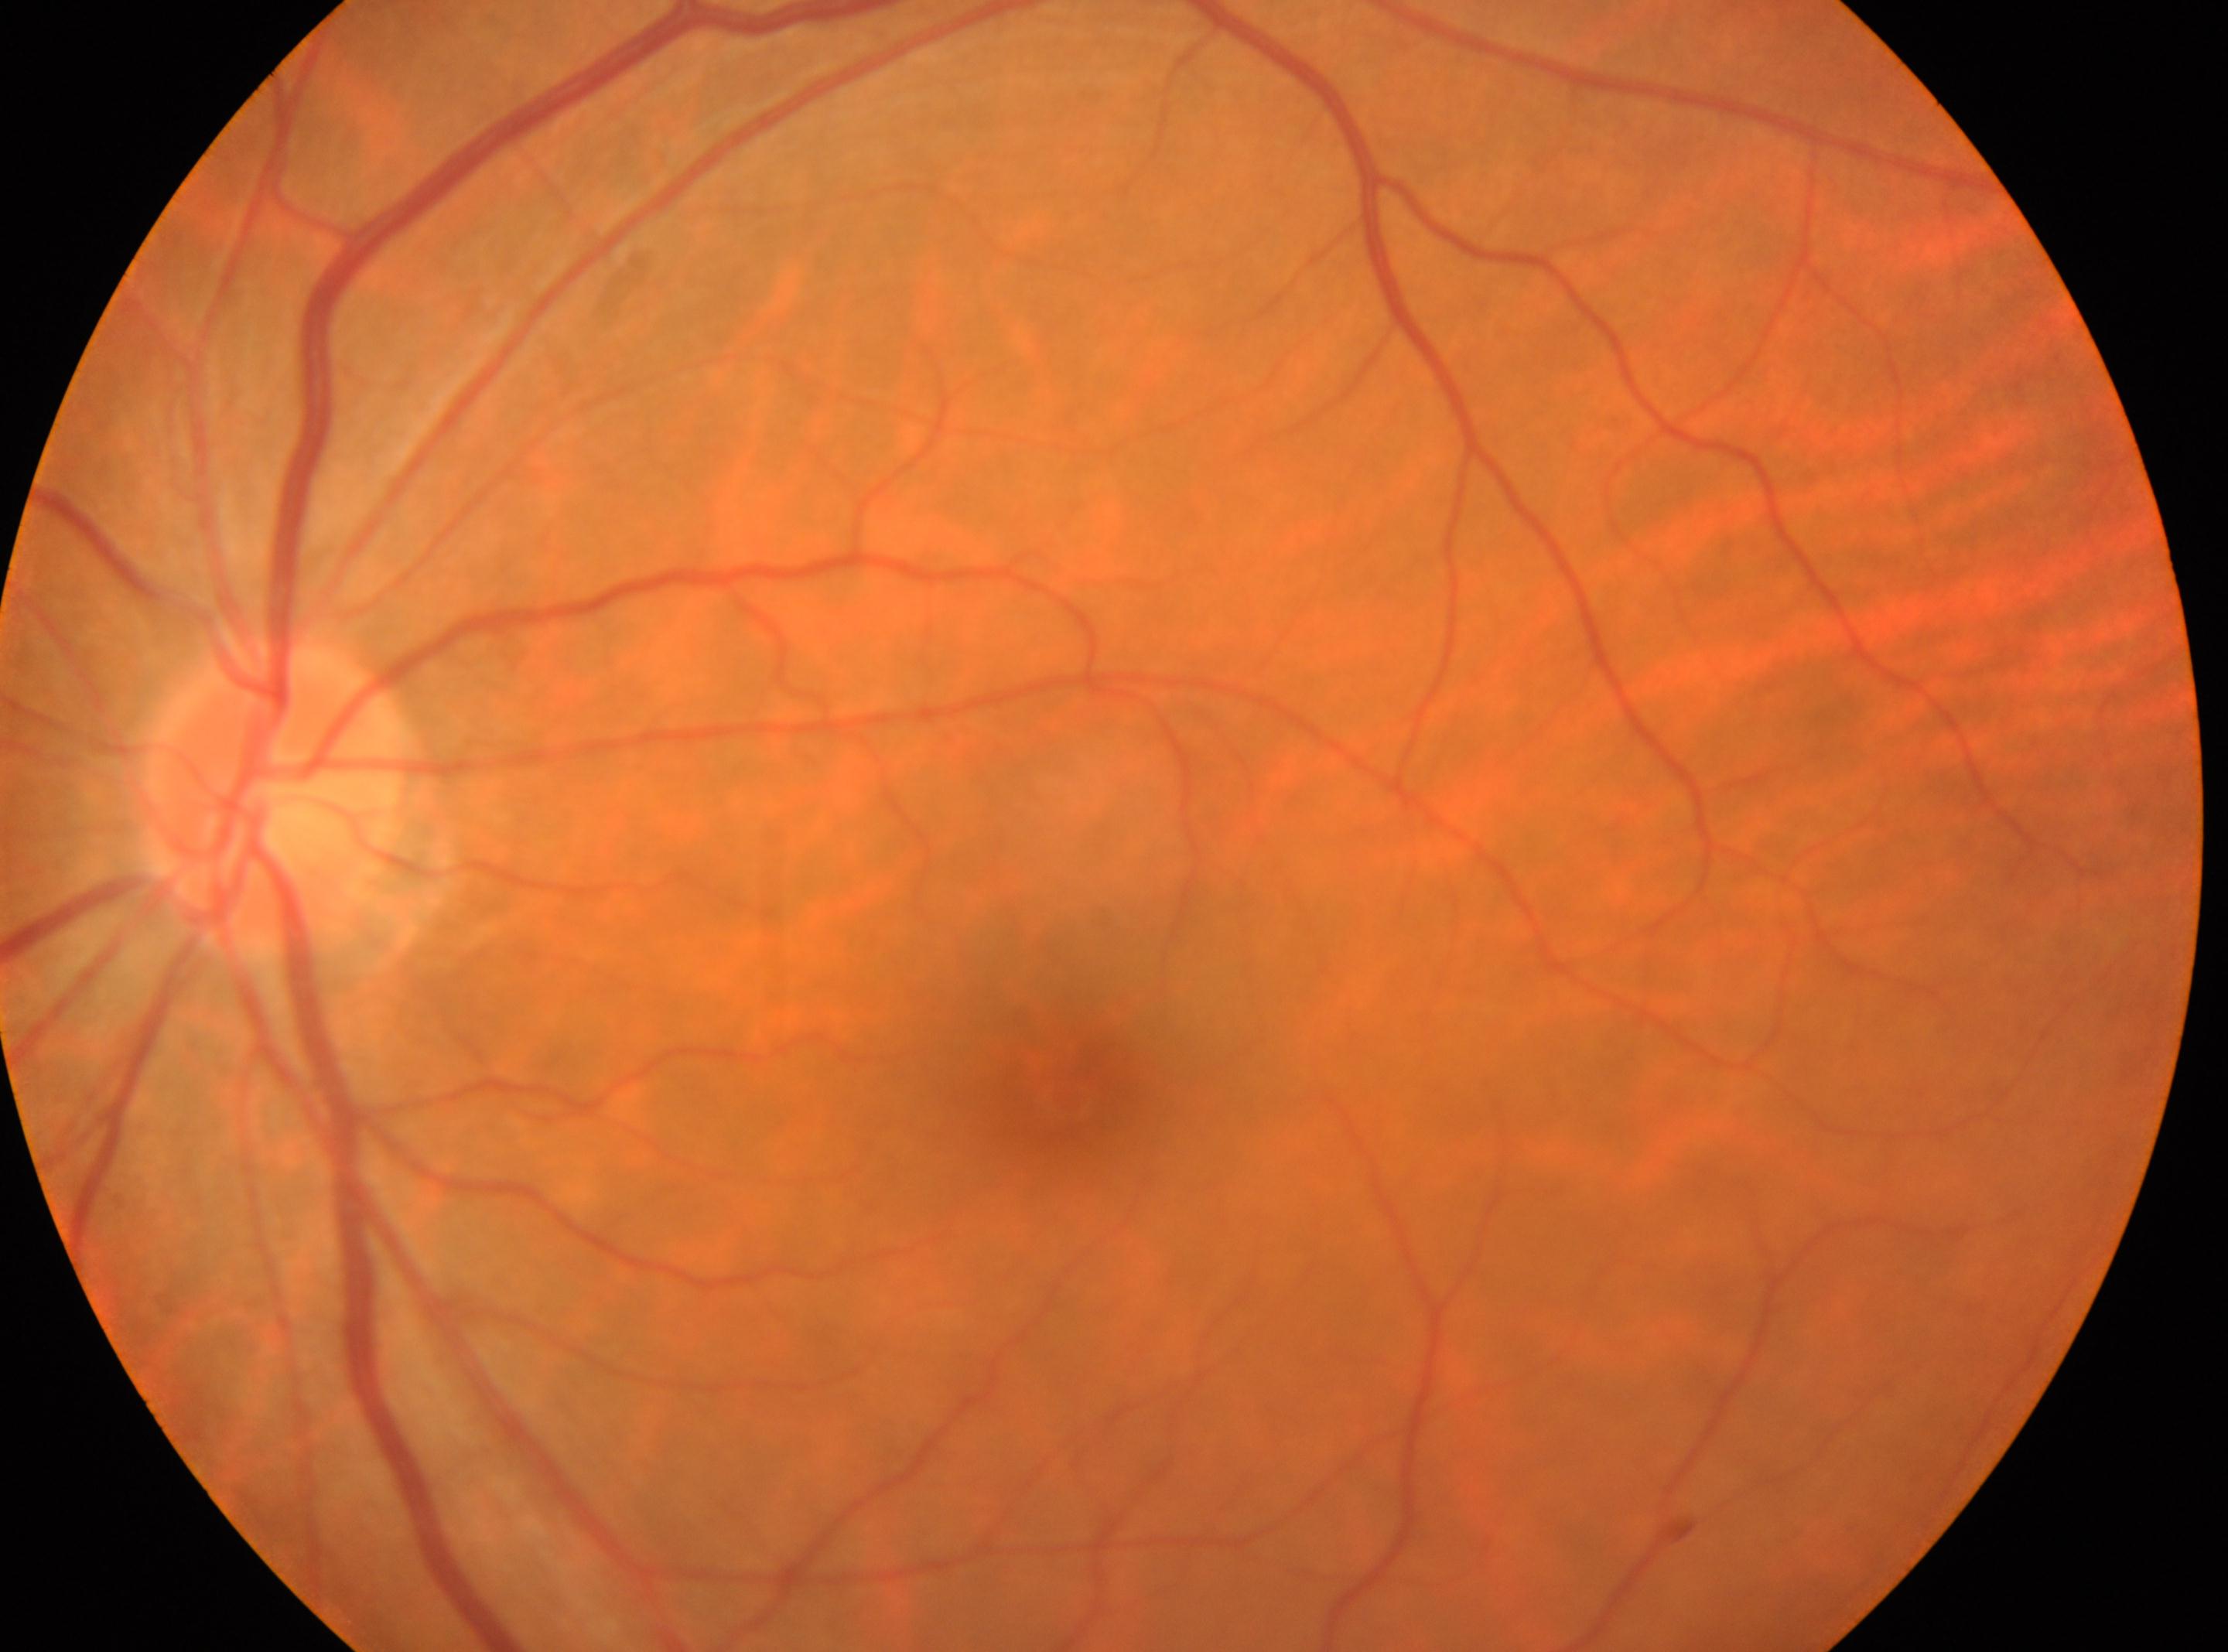
This is the left eye. The macula center is at (1074,1092). DR is 0/4. The optic disc is at (274,794).